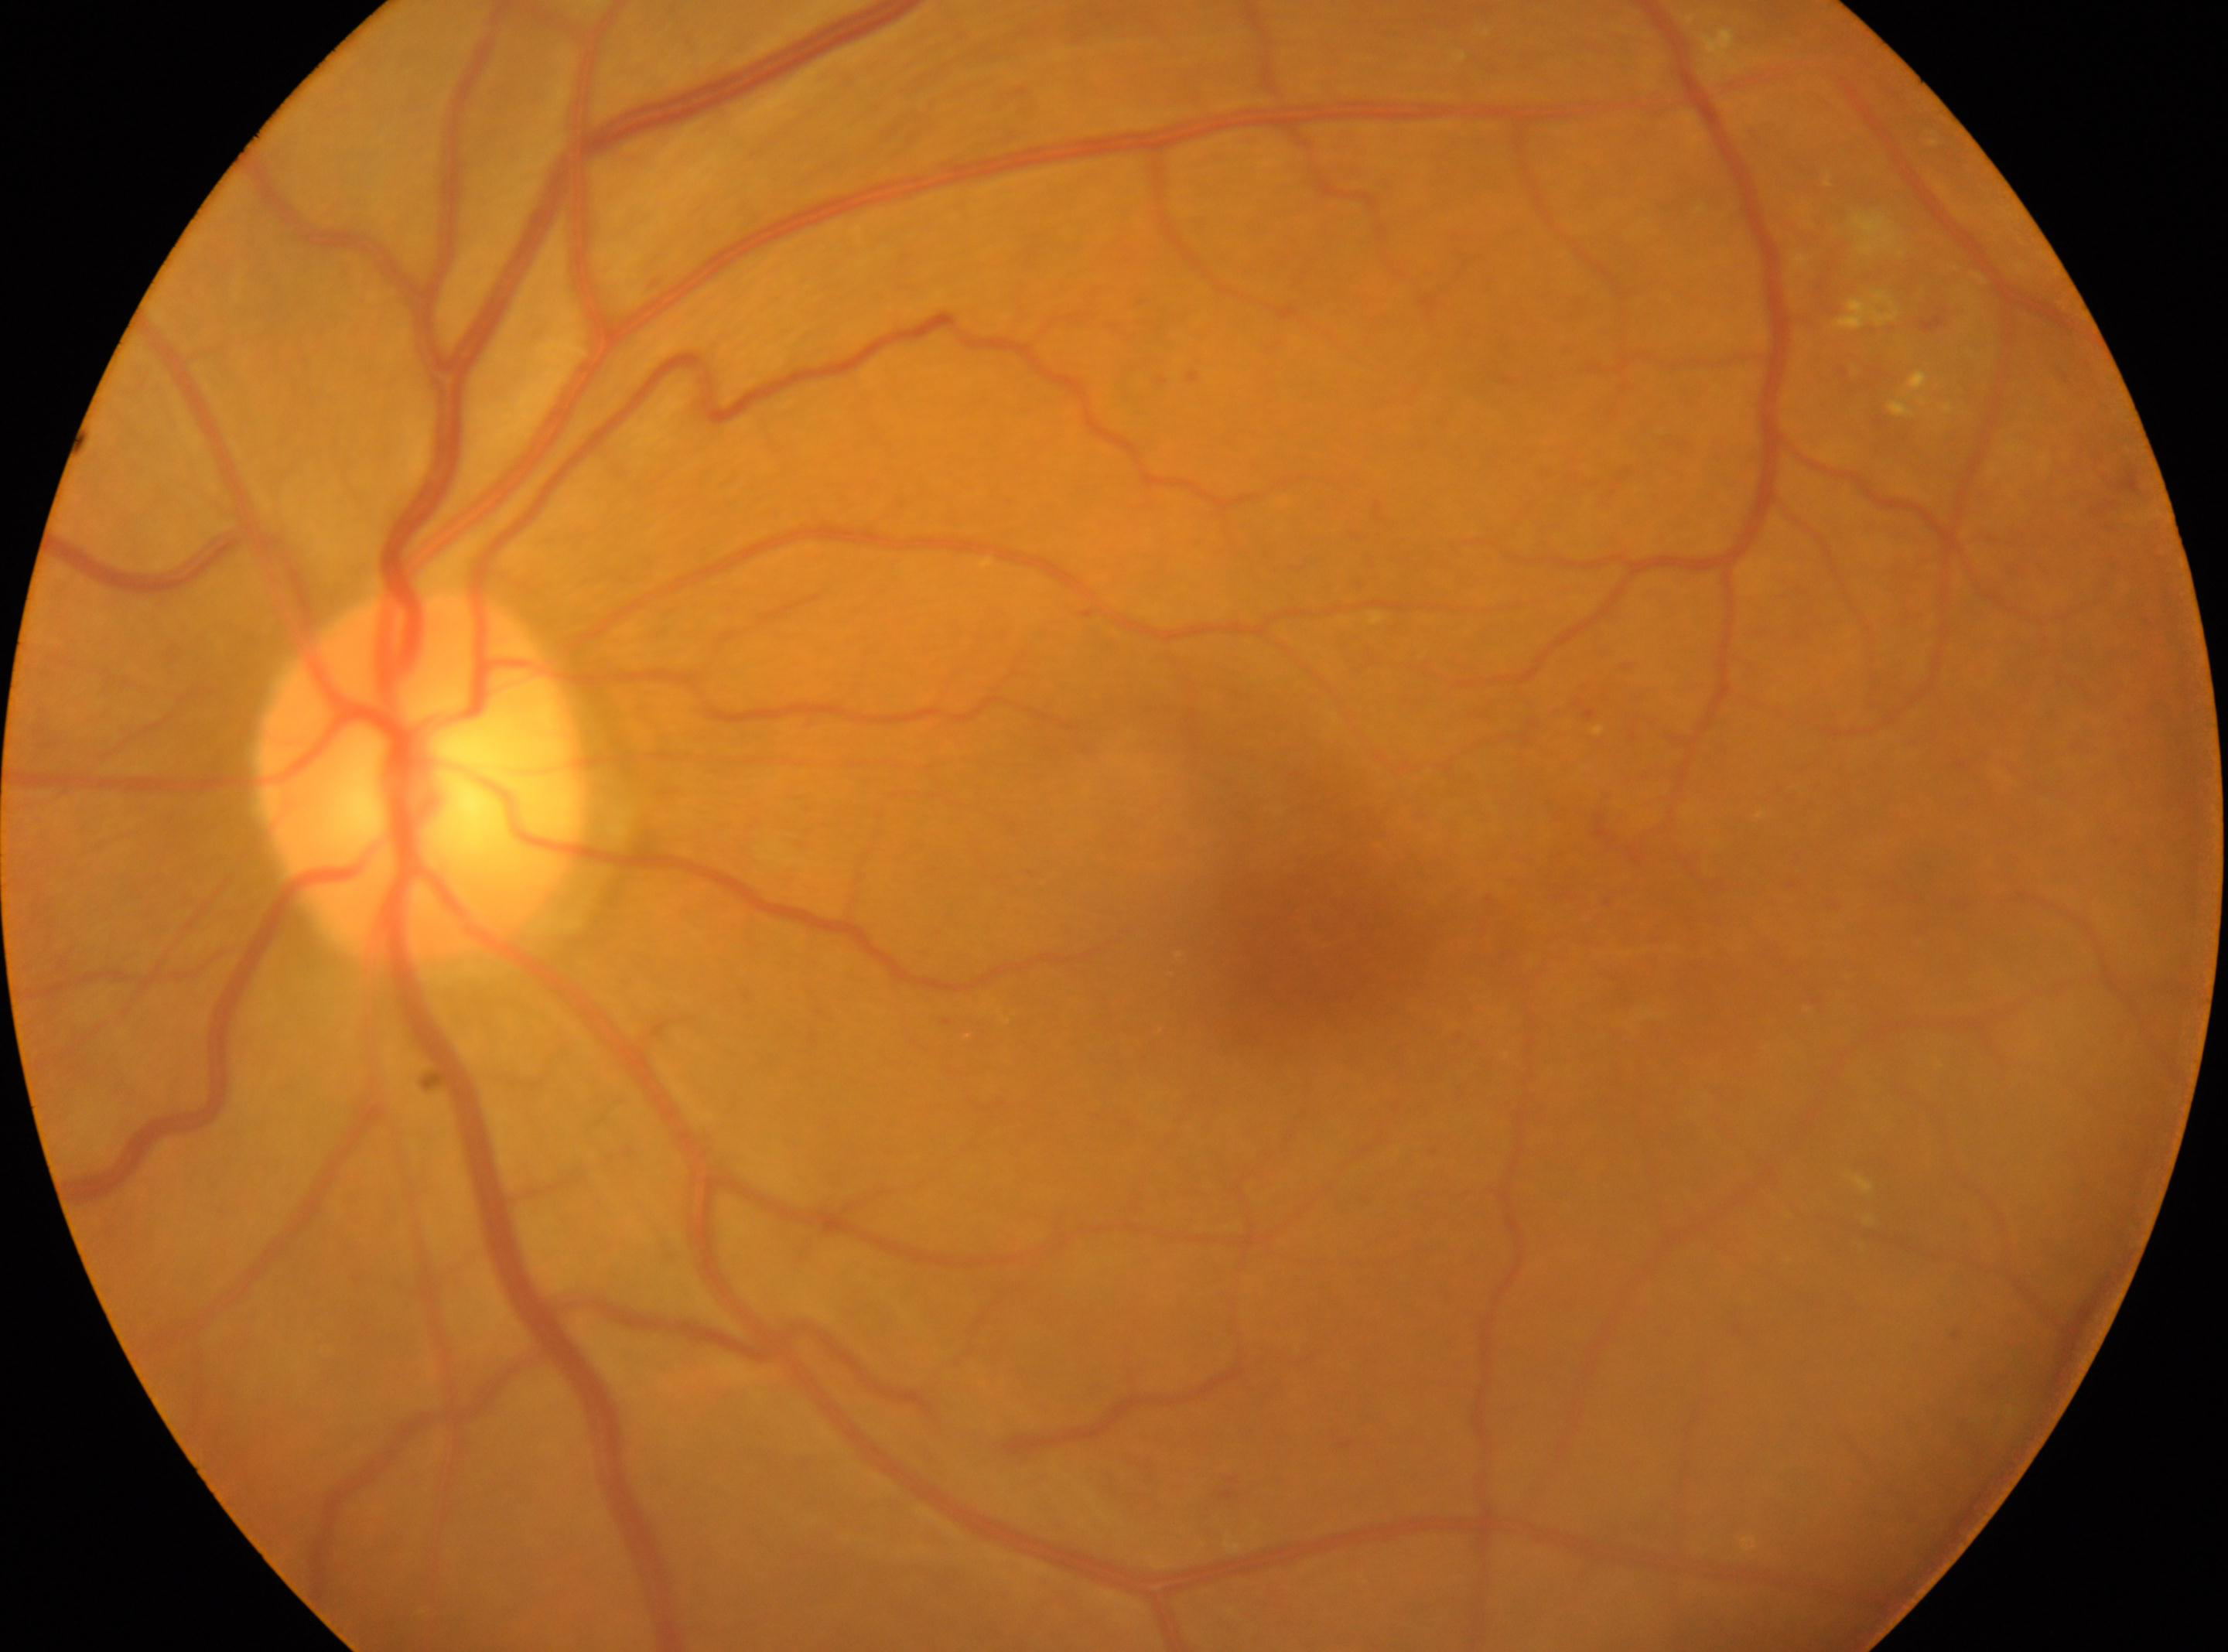
This is the oculus sinister.
The fovea is at 1321, 951.
Optic nerve head located at 422, 777.
DR class: non-proliferative diabetic retinopathy.
Diabetic retinopathy (DR): grade 2.